CFP, camera: Topcon TRC-NW8, 1932x1932px — 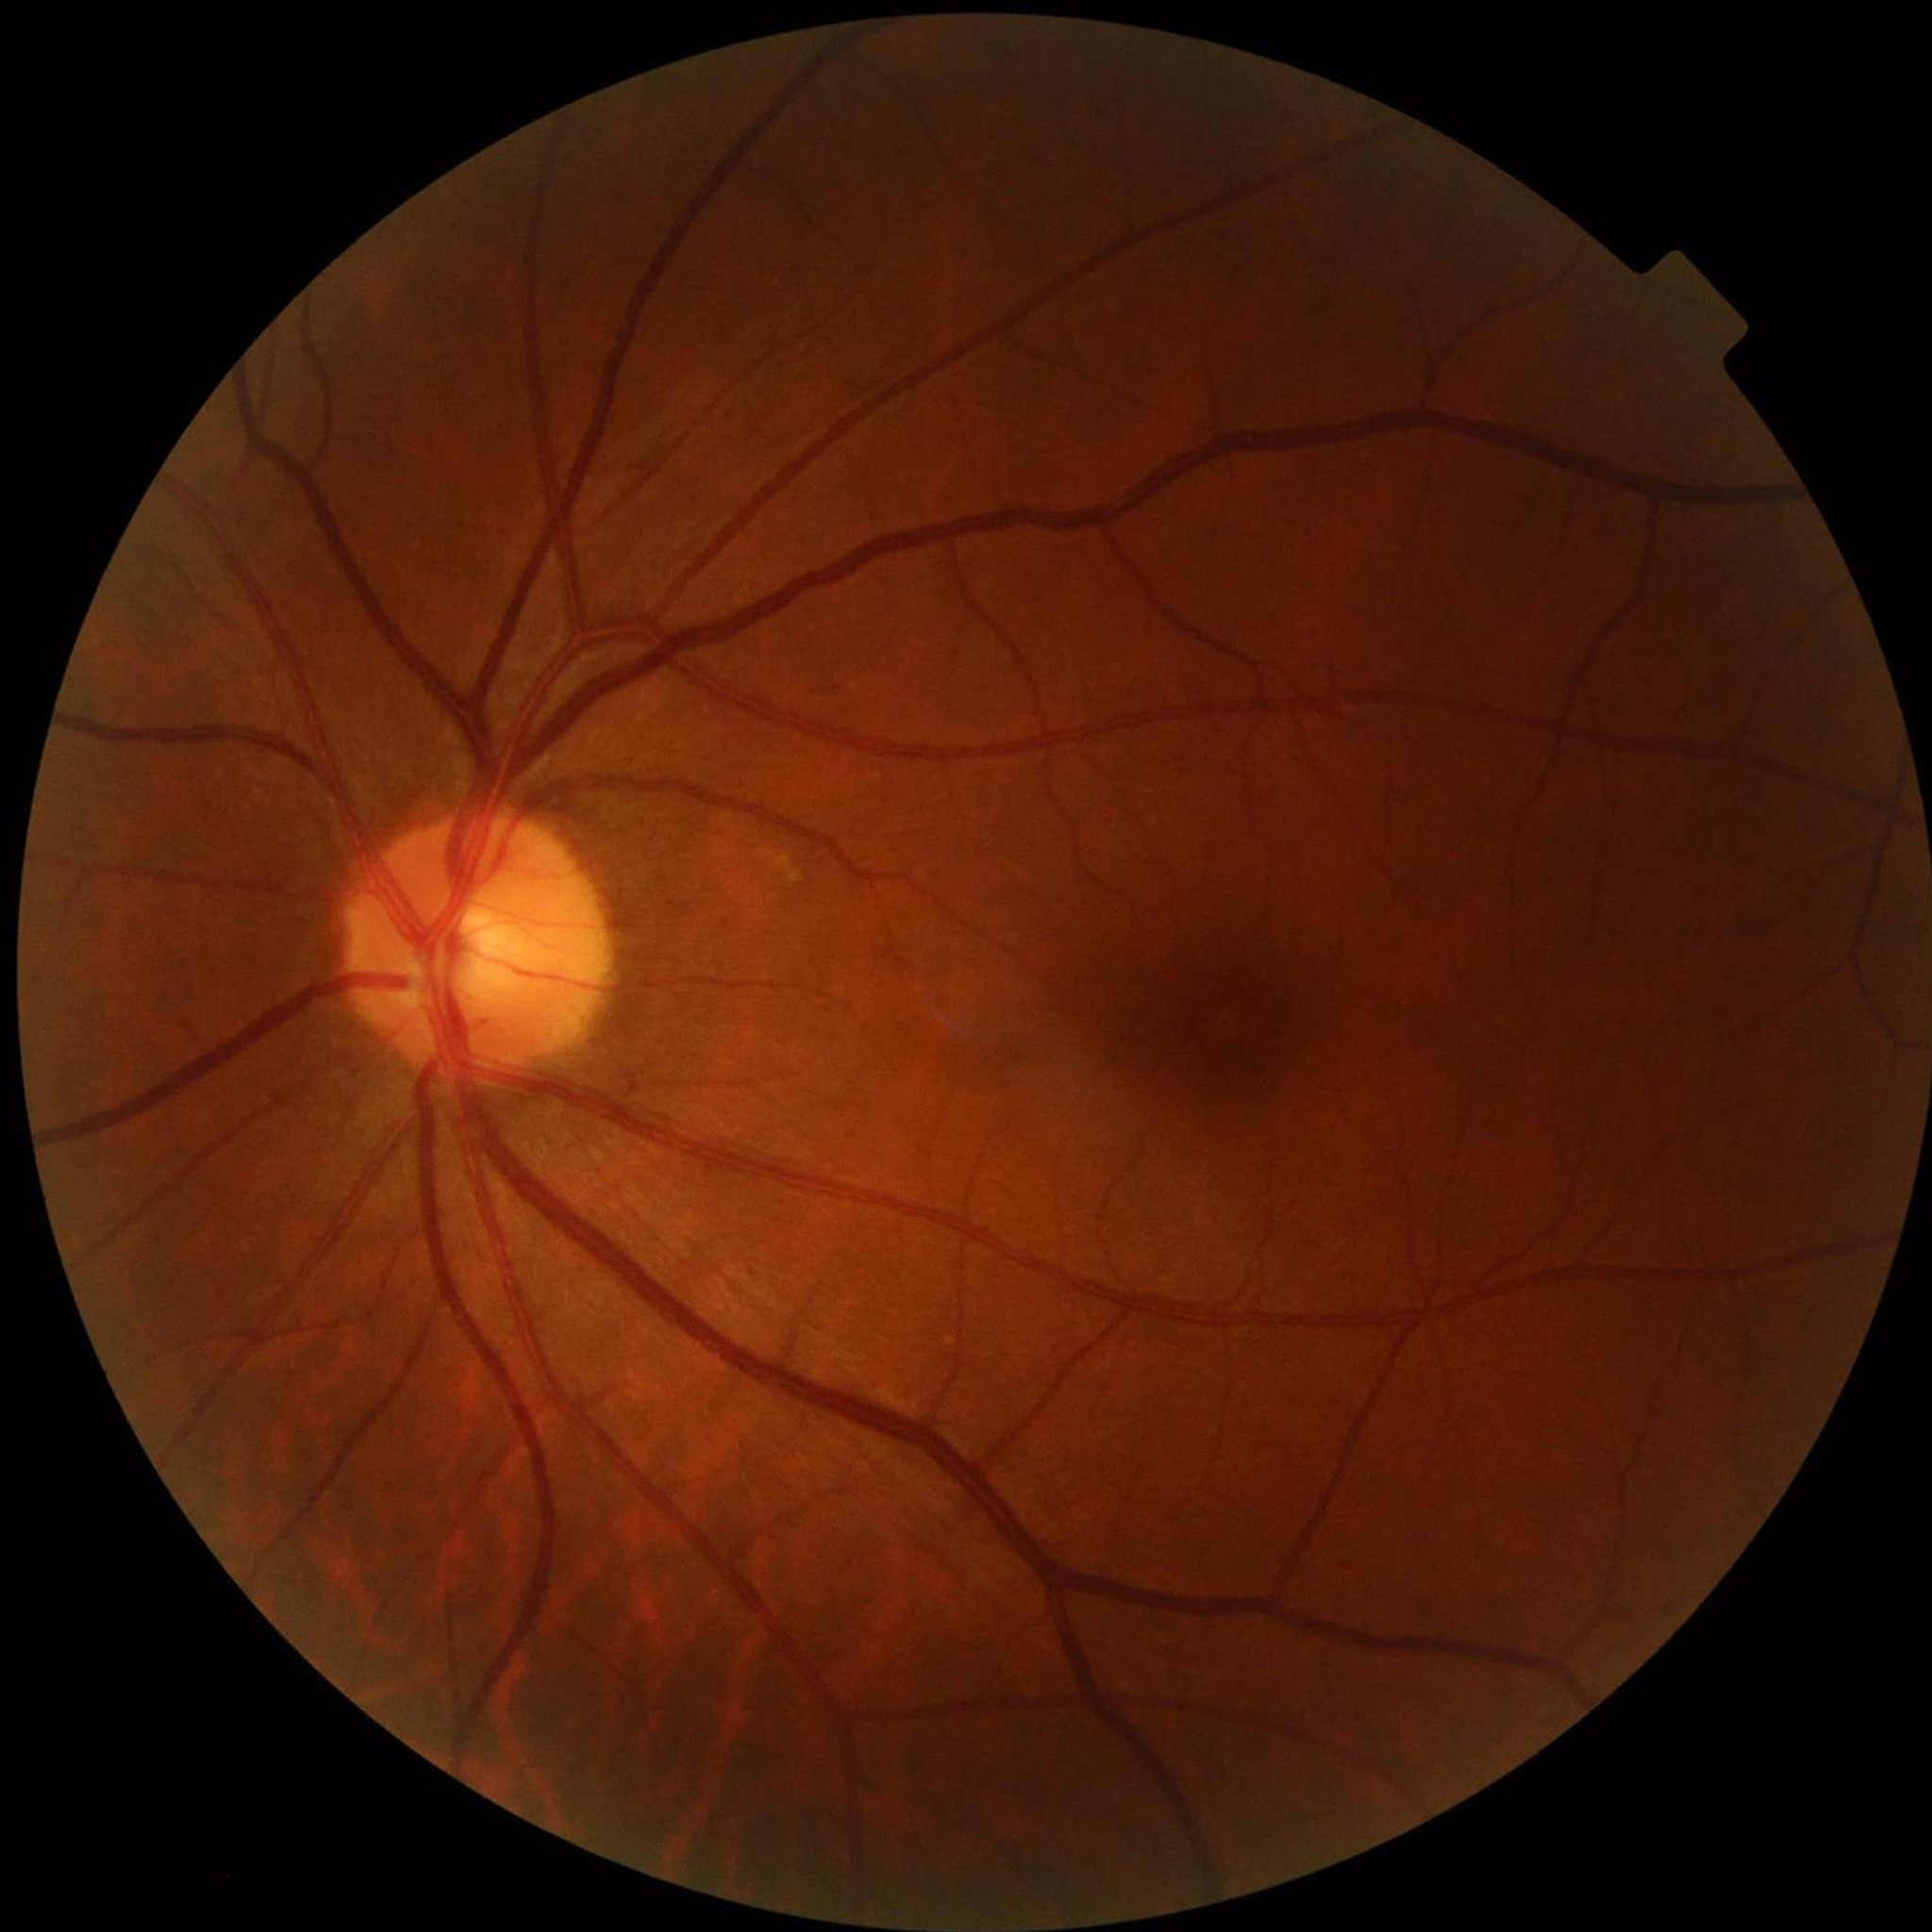

Quality: satisfactory. No AMD, DR, or glaucomatous findings.